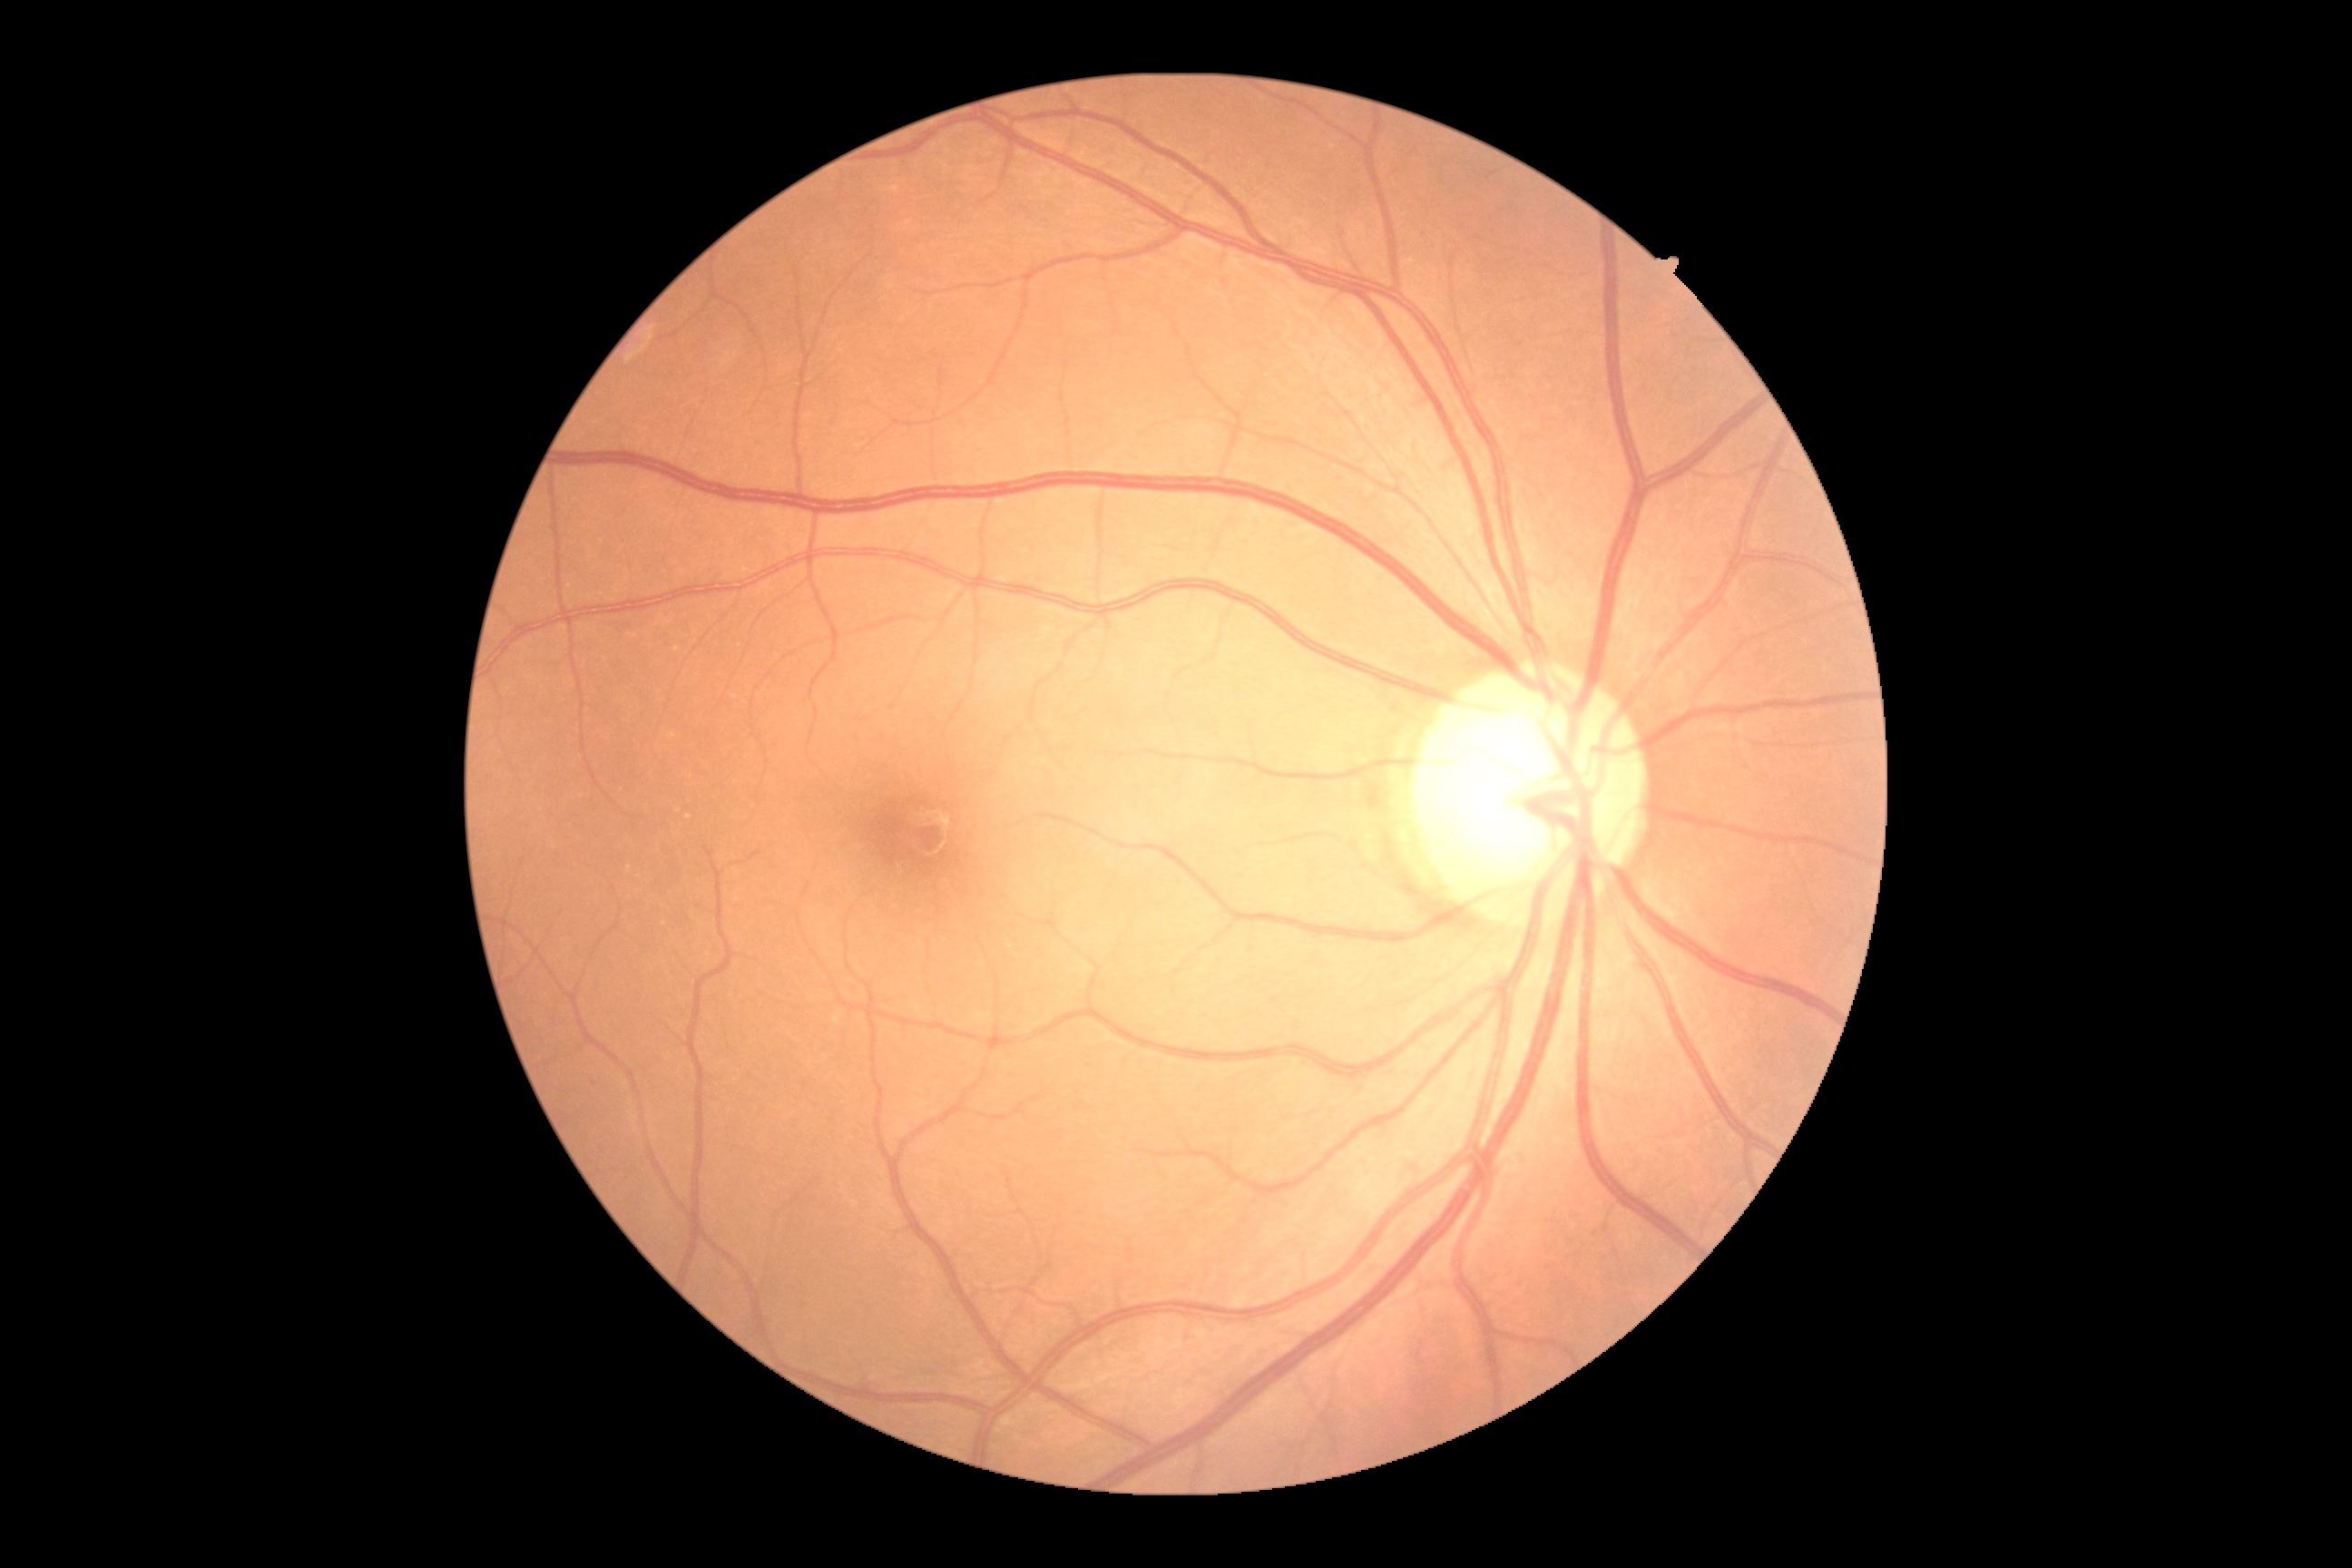
dr_grade: grade 0 (no apparent retinopathy)